Wide-field fundus photograph of an infant. Clarity RetCam 3, 130° FOV:
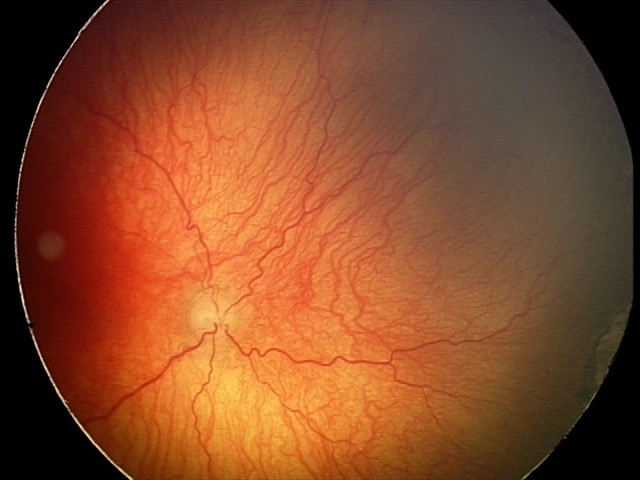
Plus disease was diagnosed.
Examination diagnosed as A-ROP (aggressive ROP) — rapidly progressive severe ROP with prominent plus disease, often without classic stage progression.